FOV: 45 degrees: 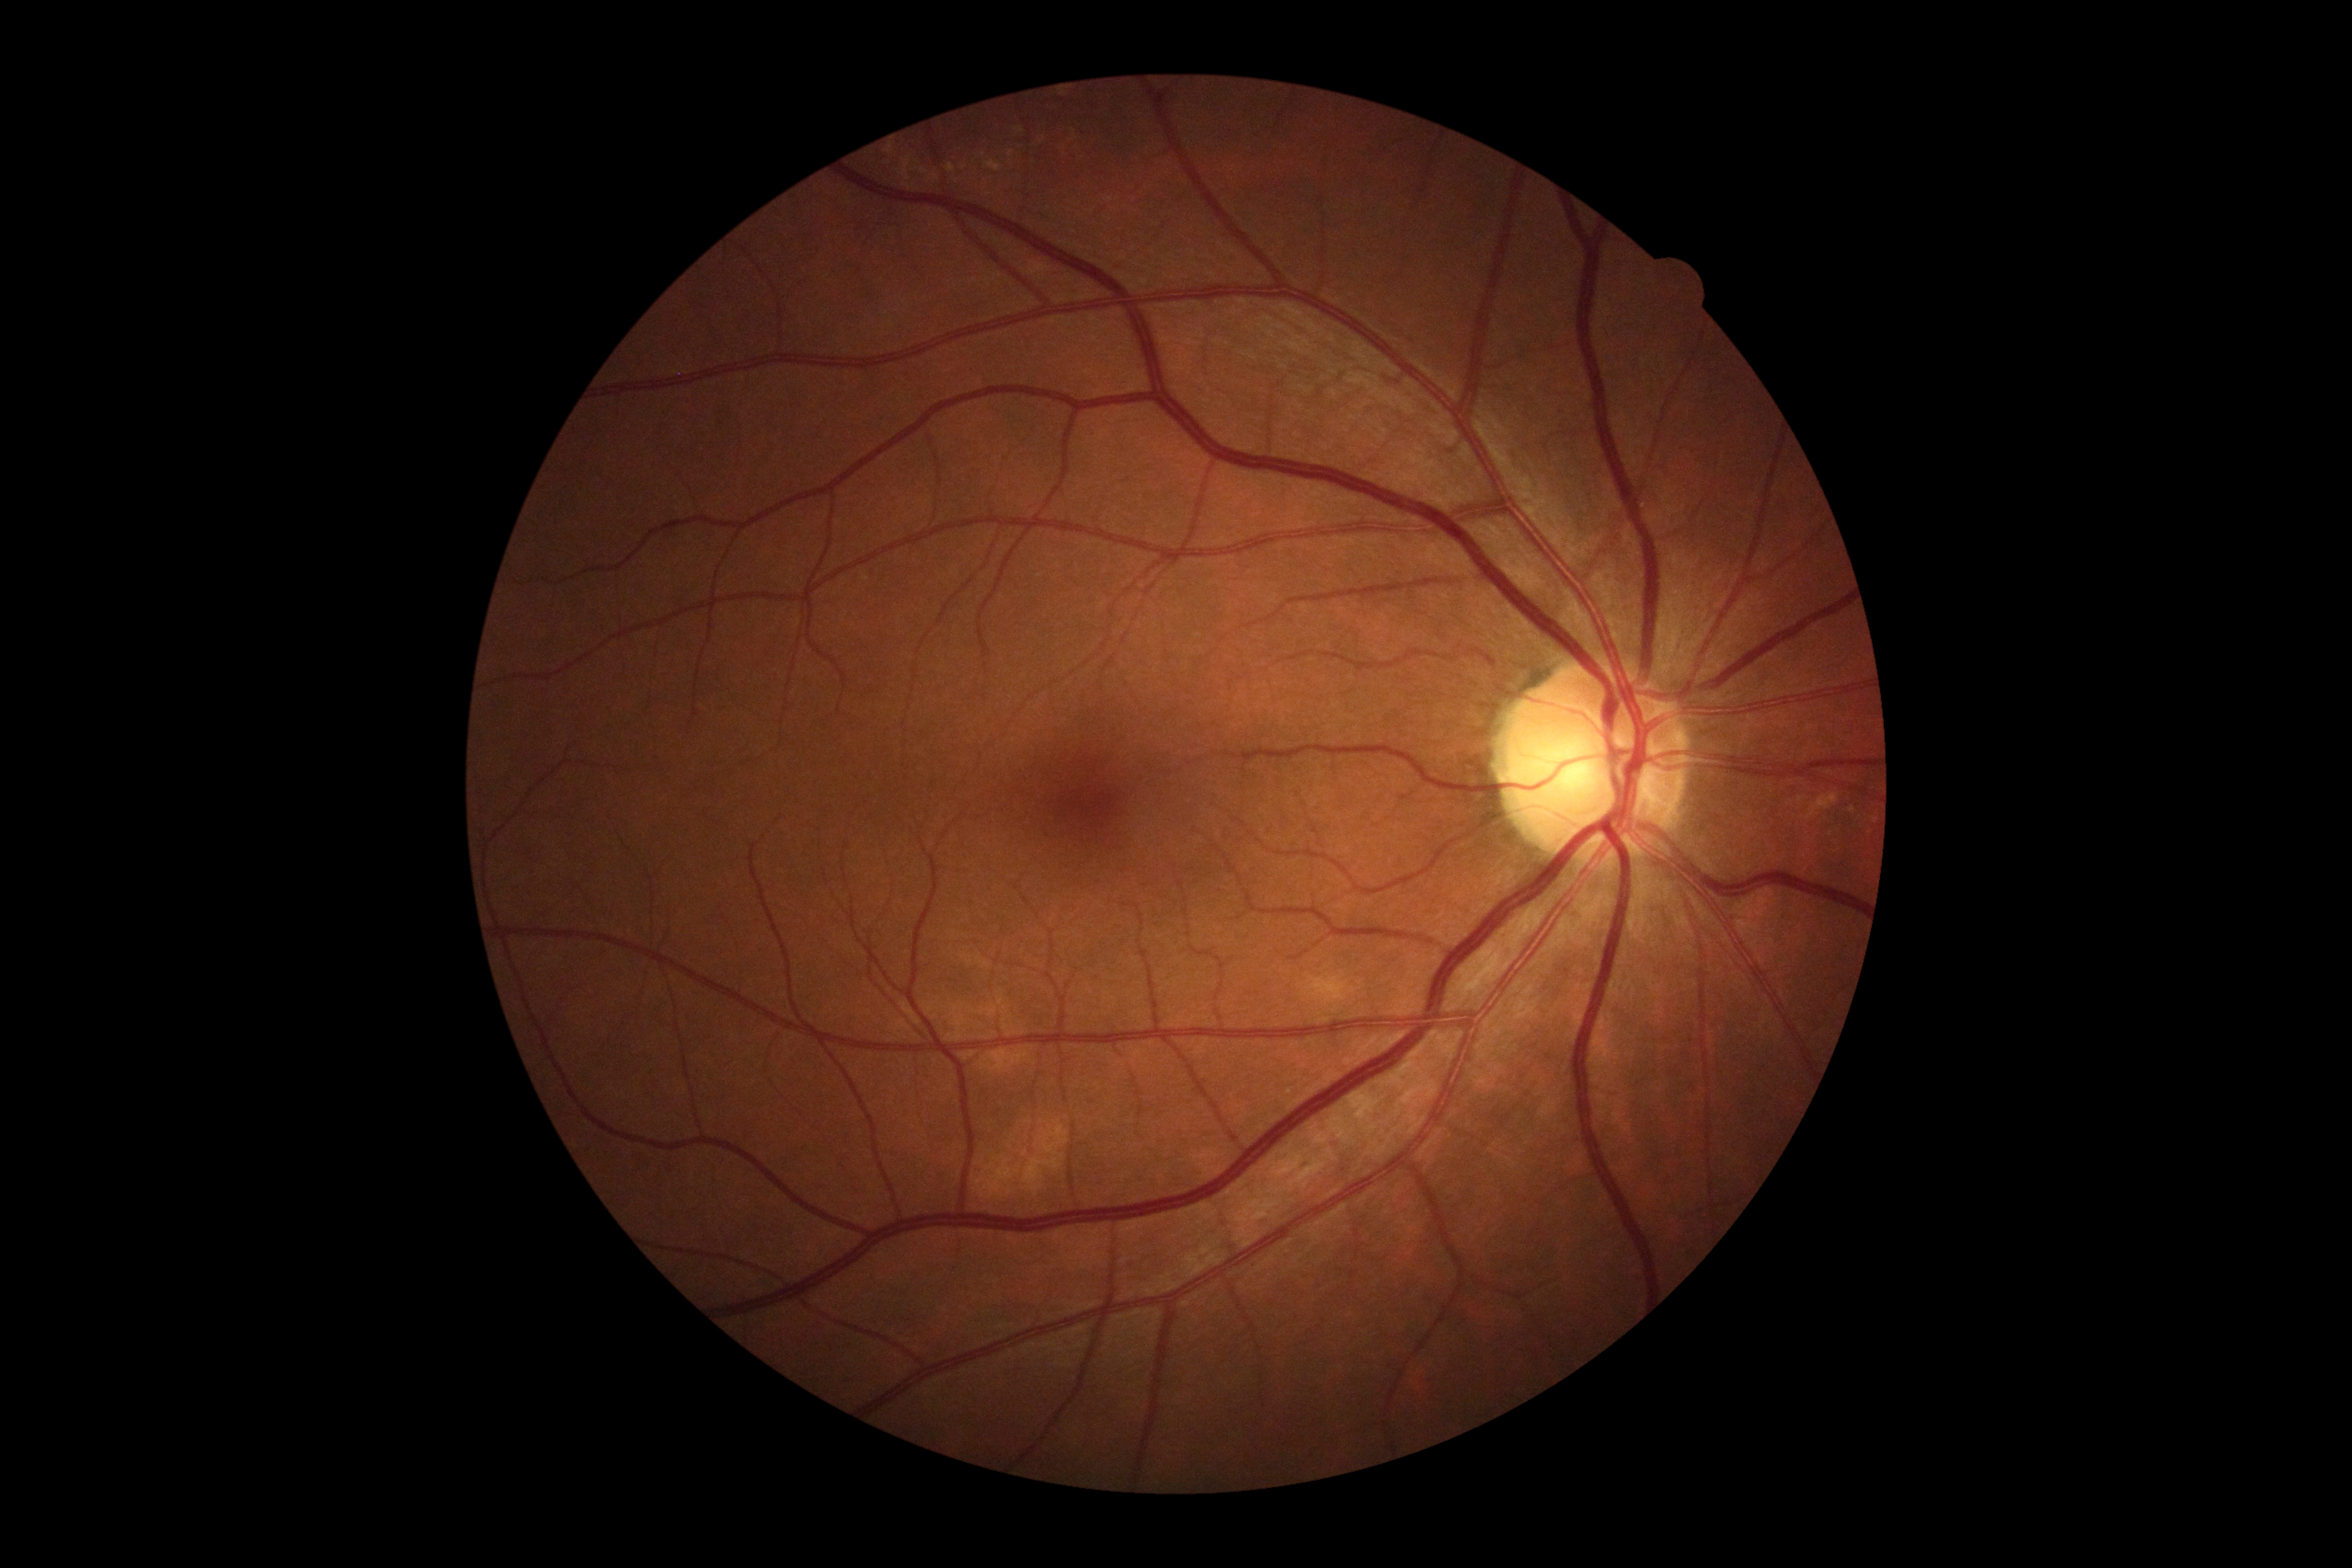

No DR findings. DR: grade 0.